Posterior pole color fundus photograph, 45° field of view, 848x848px: 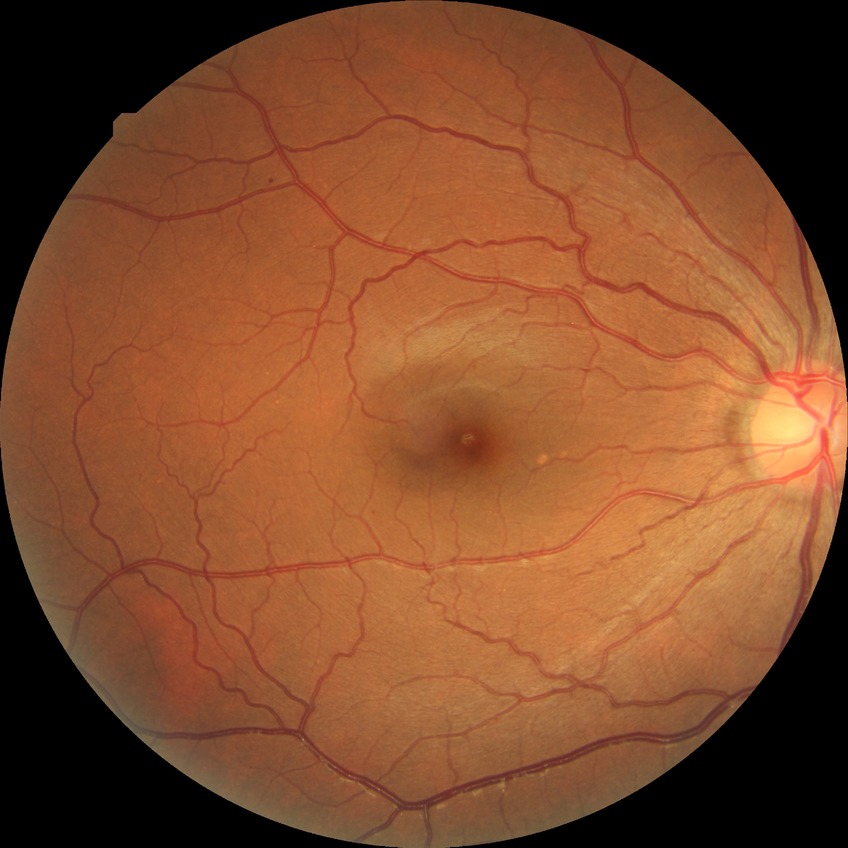

Davis DR grade: SDR.